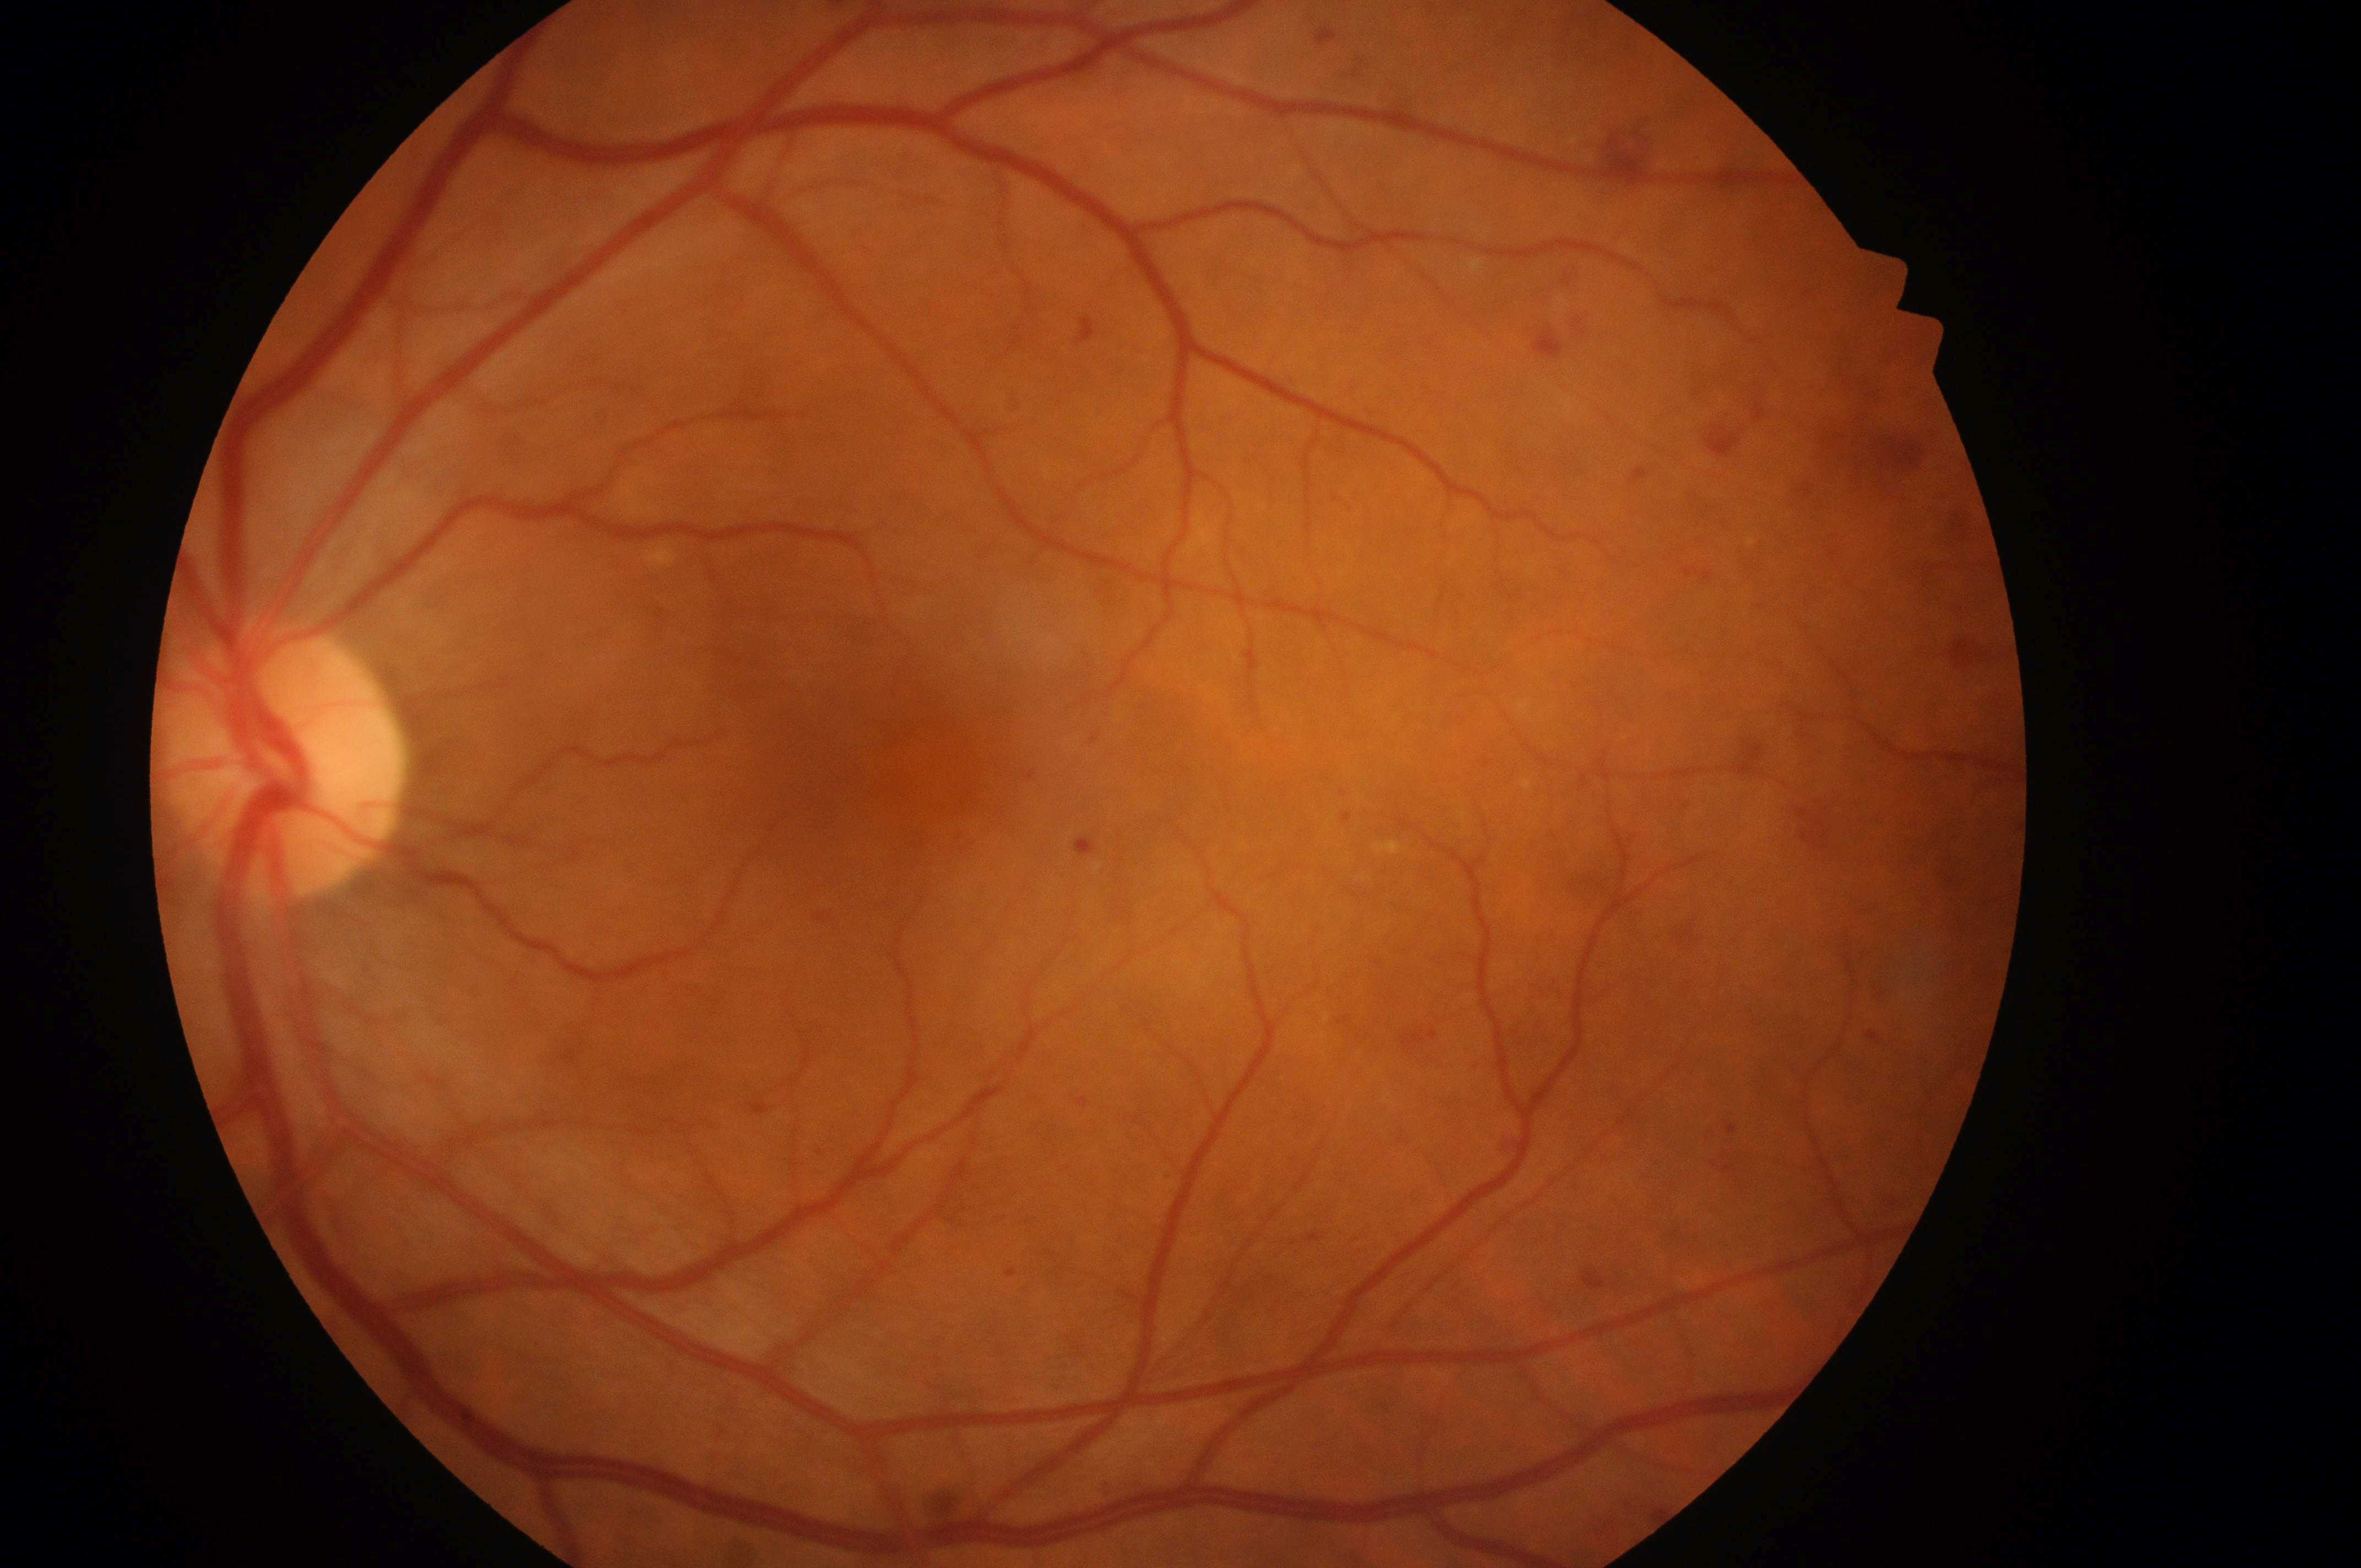 Annotations:
- DR grade — moderate non-proliferative diabetic retinopathy (2)
- disc center — [282, 771]
- macula center — [934, 765]
- DME grade — 2 (high risk)
- laterality — left eye